2352x1568px · fundus photo · 45-degree field of view.
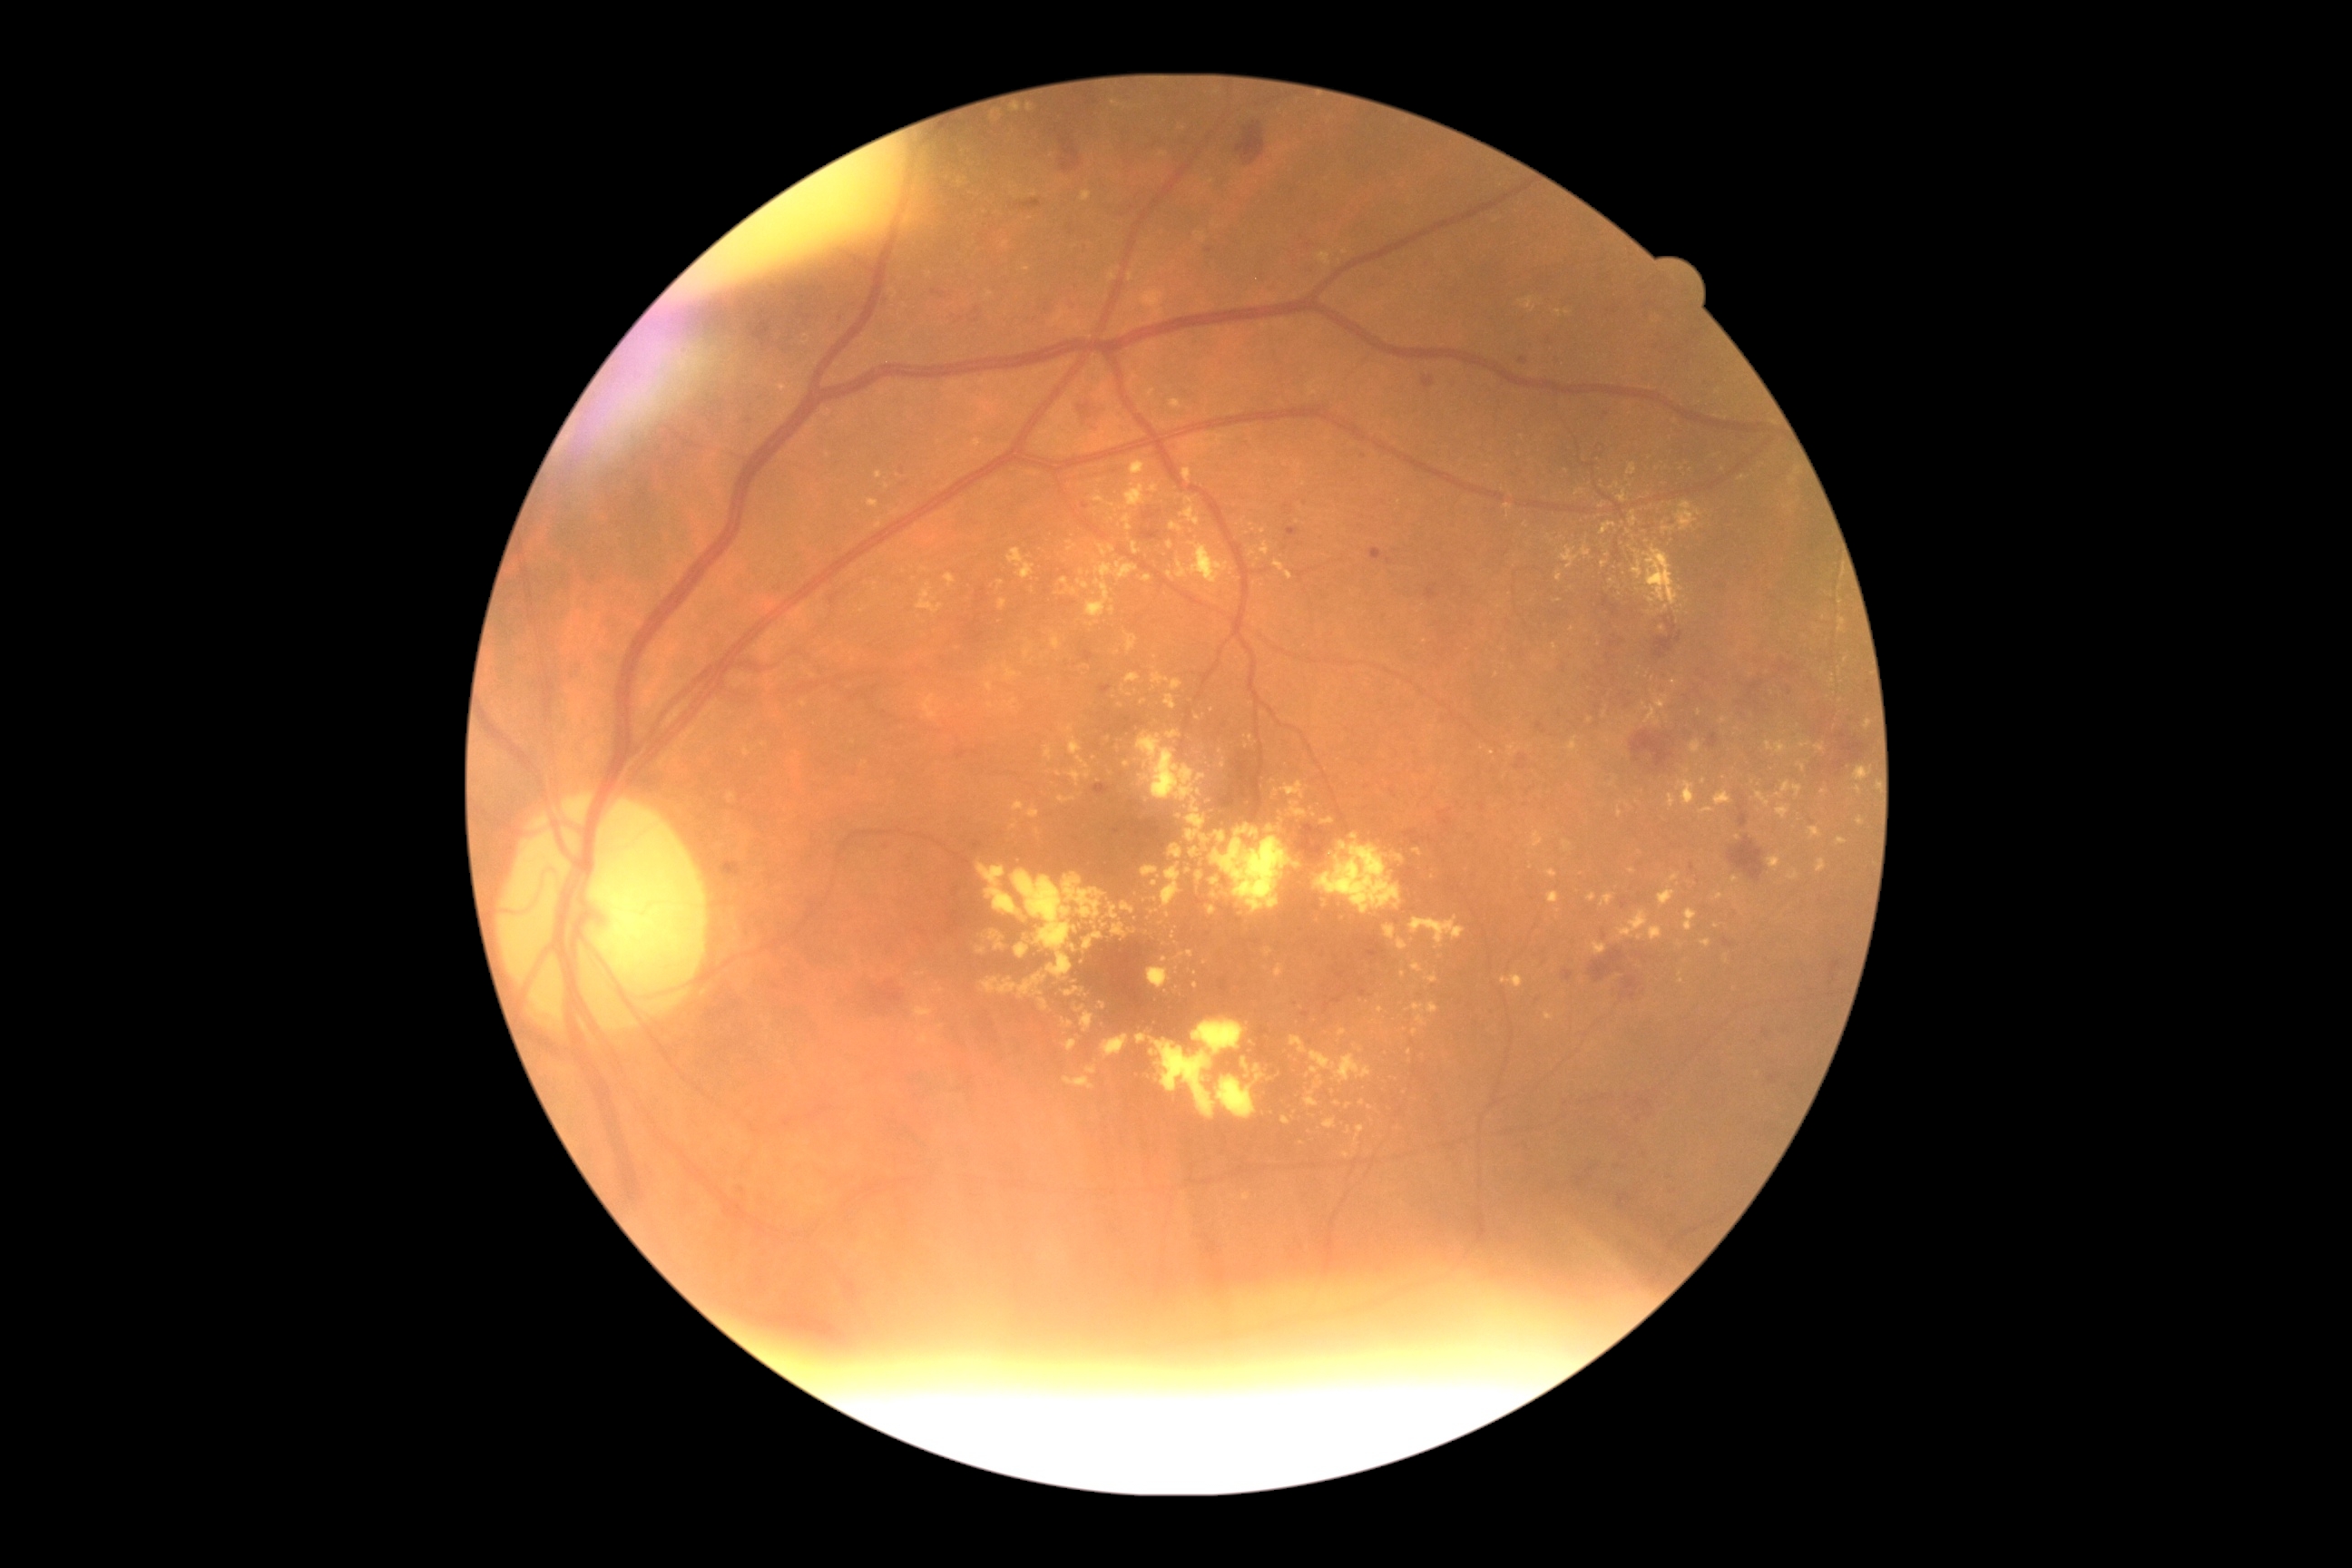 <lesions partial="true">
  <dr_grade>2</dr_grade>
  <ex partial="true">(x1=1015, y1=945, x2=1030, y2=959), (x1=1181, y1=496, x2=1200, y2=525), (x1=1004, y1=665, x2=1023, y2=681), (x1=1077, y1=580, x2=1090, y2=591), (x1=1081, y1=191, x2=1092, y2=202), (x1=745, y1=749, x2=750, y2=758), (x1=1654, y1=484, x2=1667, y2=496), (x1=1220, y1=760, x2=1226, y2=770), (x1=1093, y1=495, x2=1104, y2=504), (x1=1137, y1=1034, x2=1146, y2=1043), (x1=1063, y1=874, x2=1106, y2=919), (x1=959, y1=179, x2=966, y2=188)</ex>
  <ex_small>(x=1602, y=506), (x=1120, y=707), (x=989, y=486), (x=1349, y=1131), (x=1491, y=754), (x=1572, y=629), (x=1170, y=576)</ex_small>
</lesions>